2212x1659.
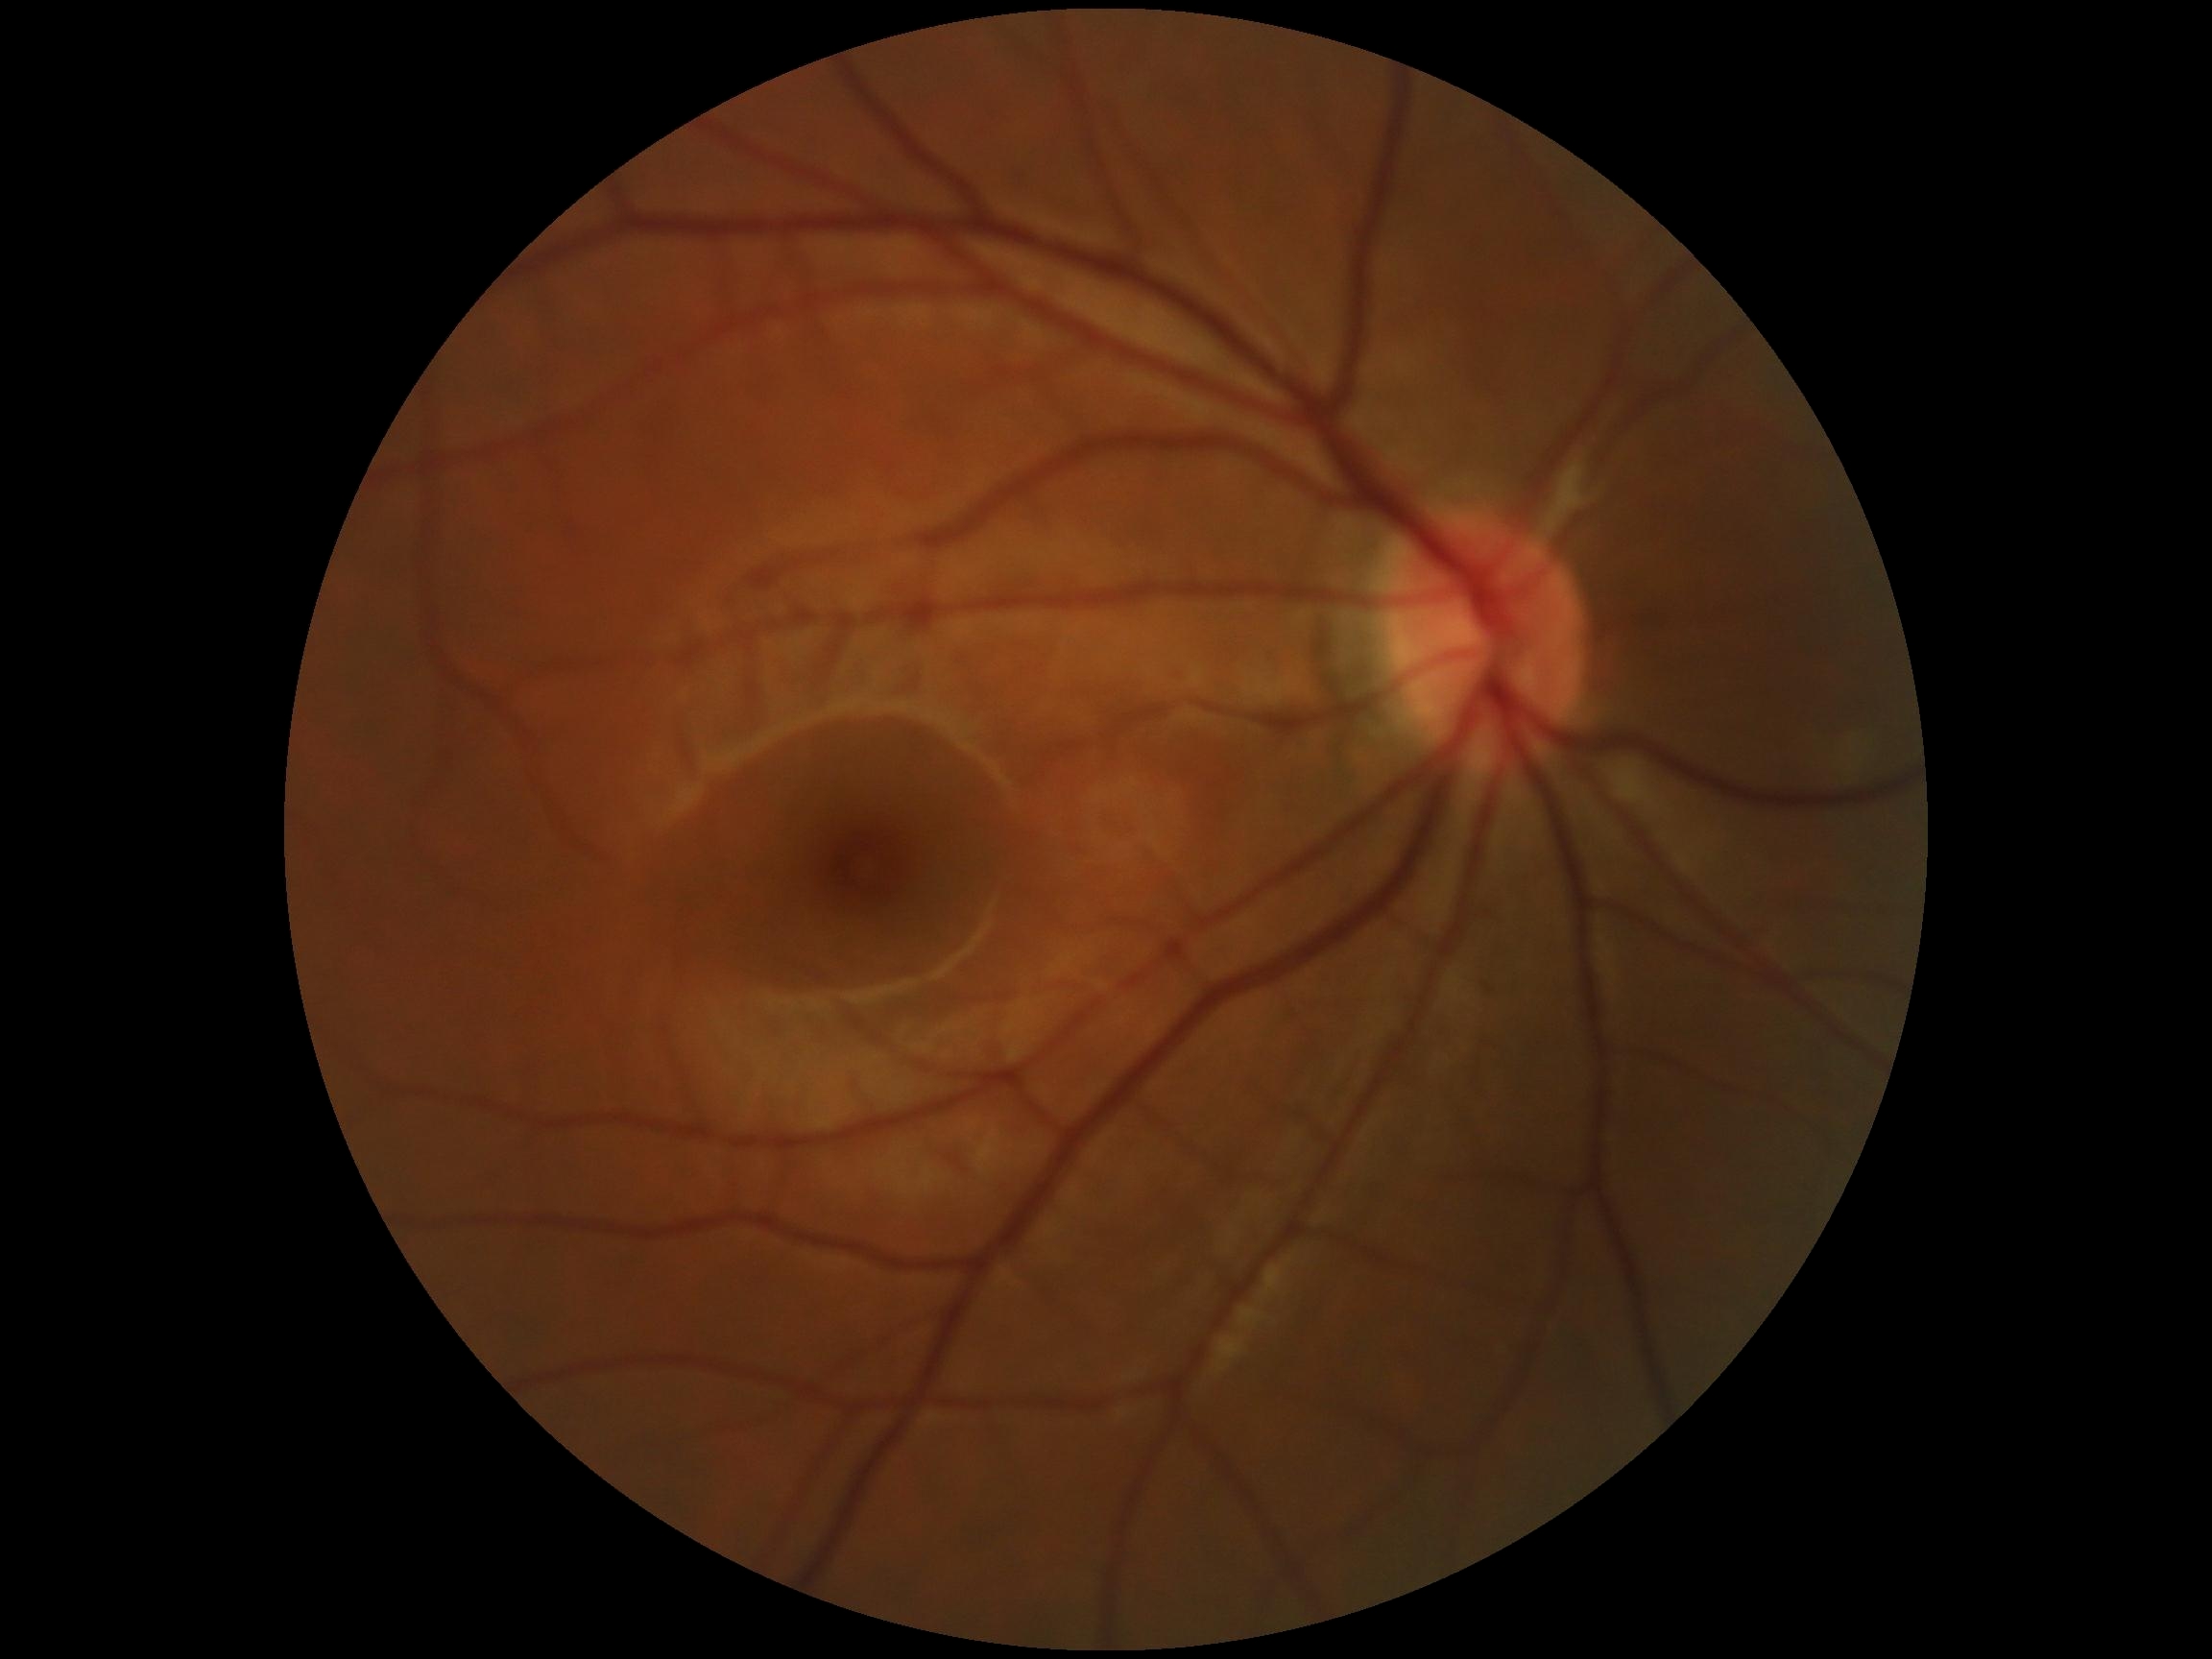

No diabetic retinal disease findings.
DR severity is grade 0 (no apparent retinopathy).